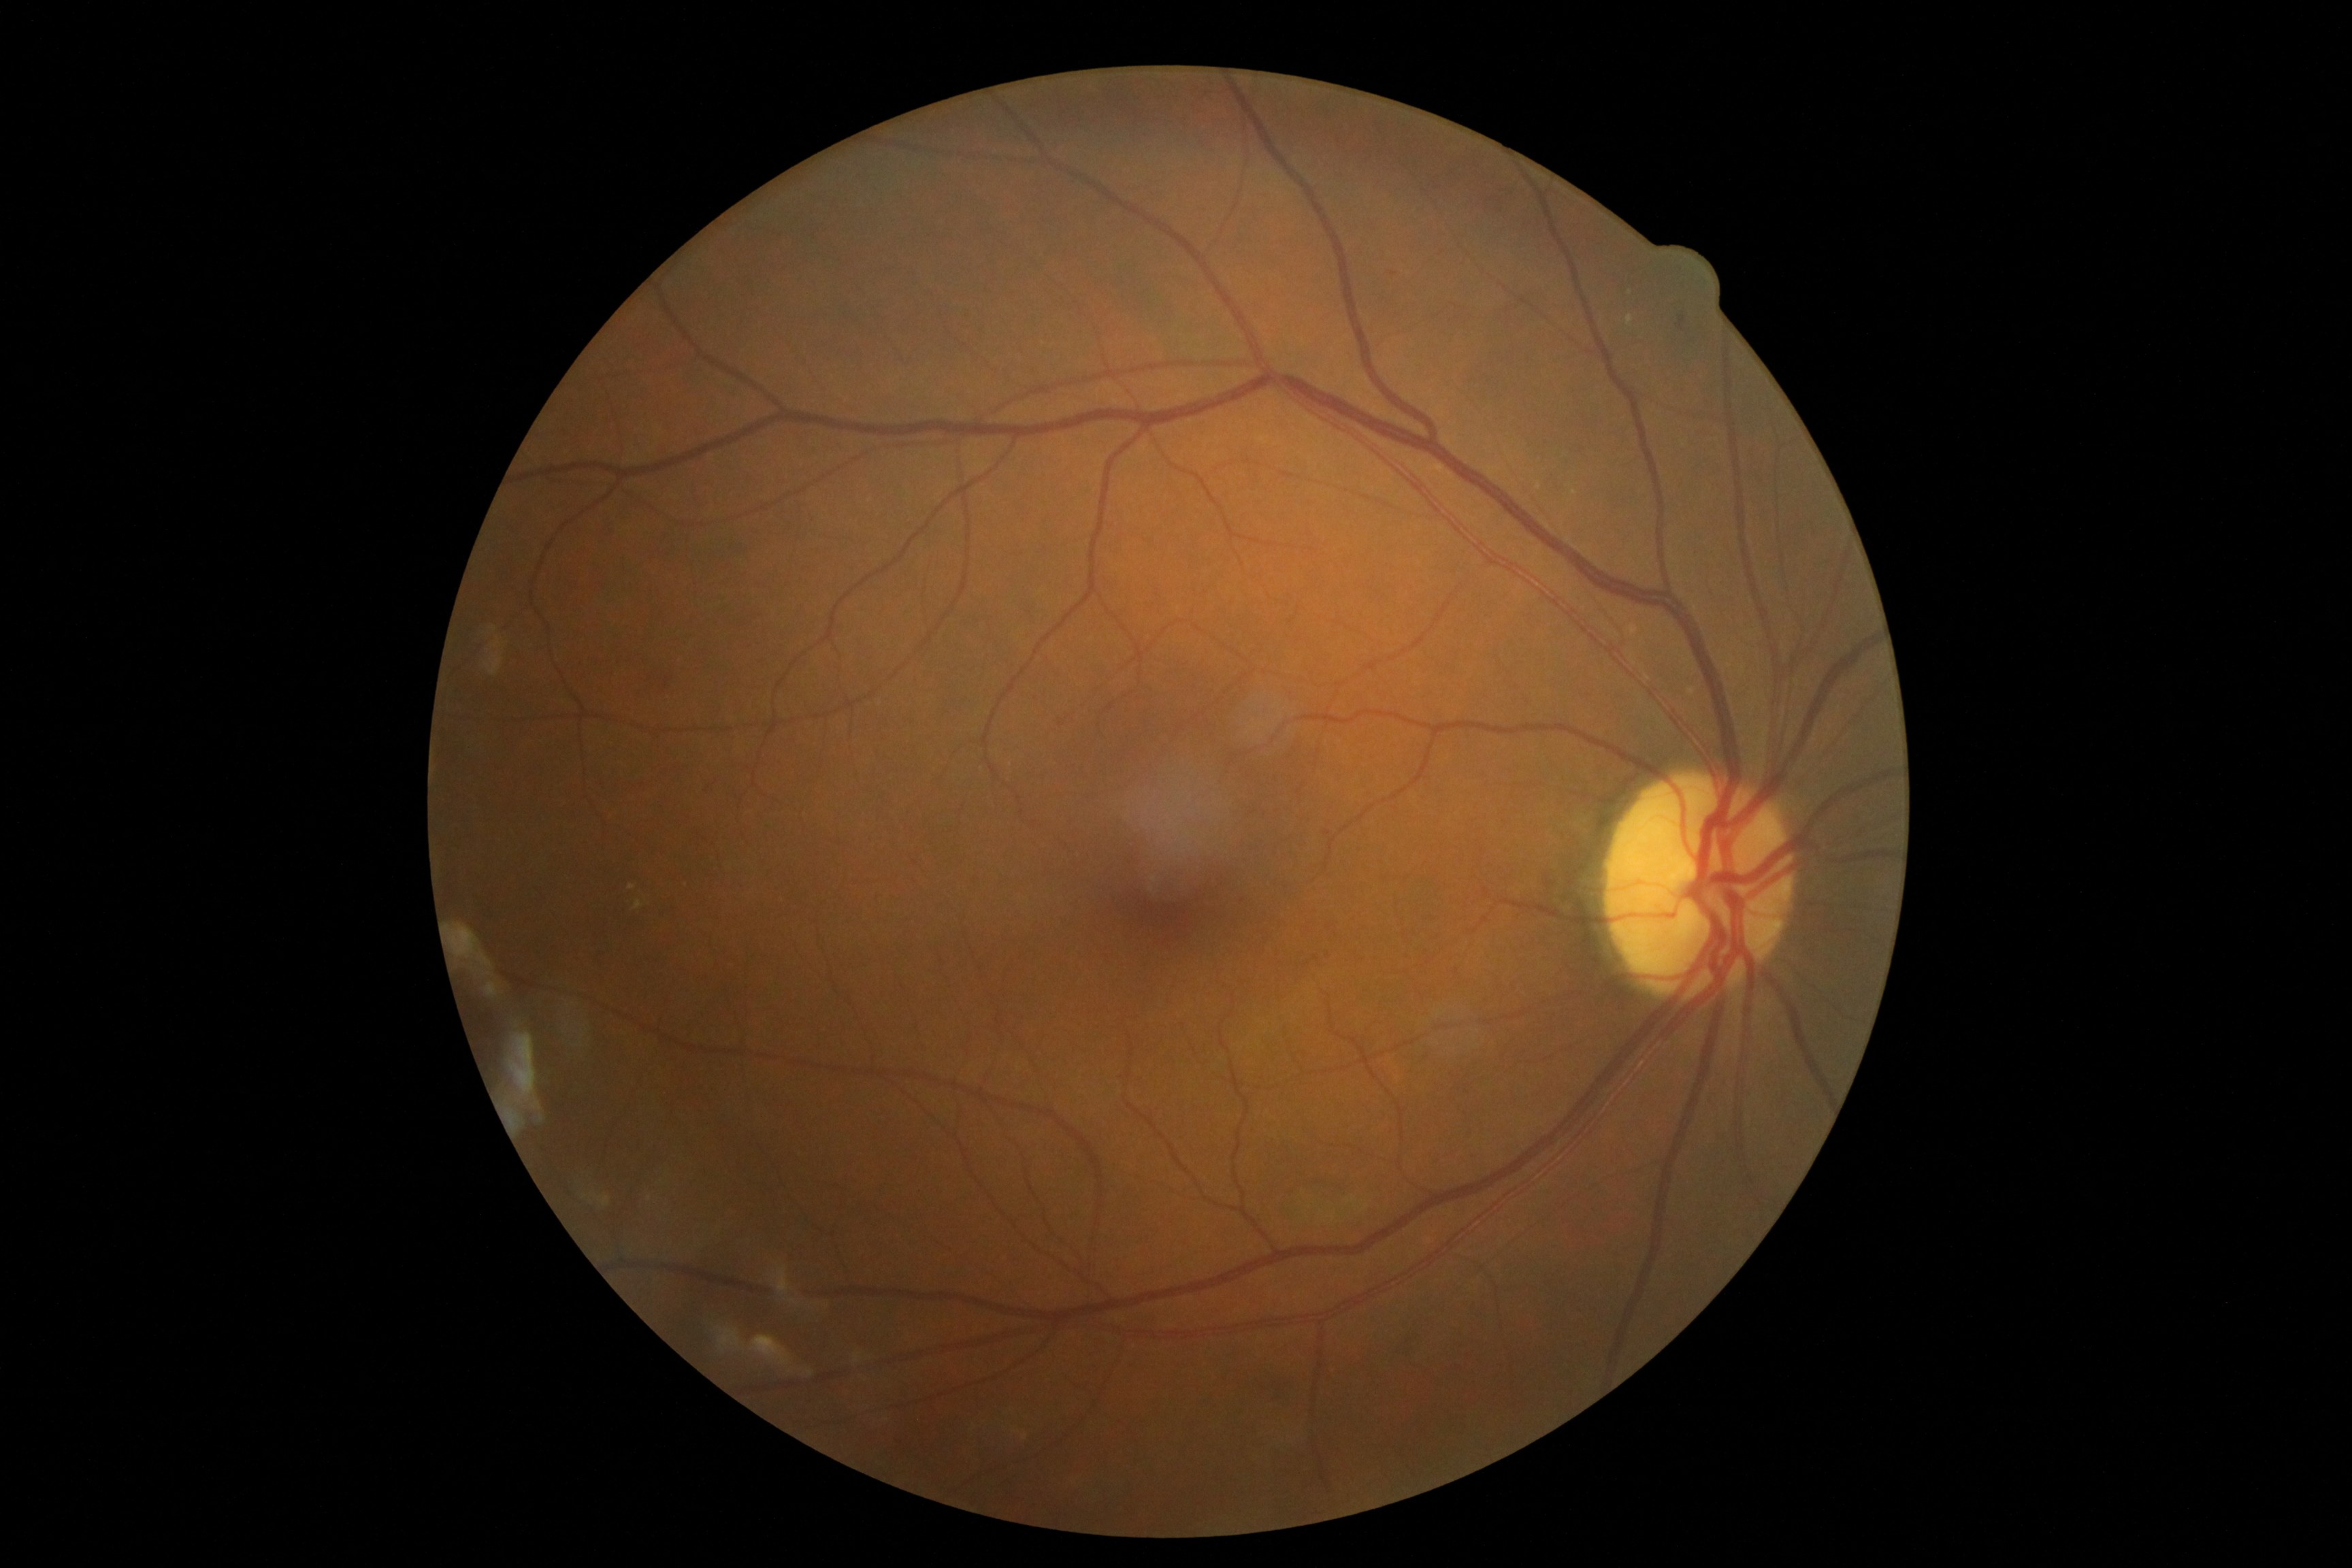
DR severity is grade 2 (moderate NPDR). Disease class: non-proliferative diabetic retinopathy.